Retinal fundus photograph; 45° FOV; image size 2352x1568
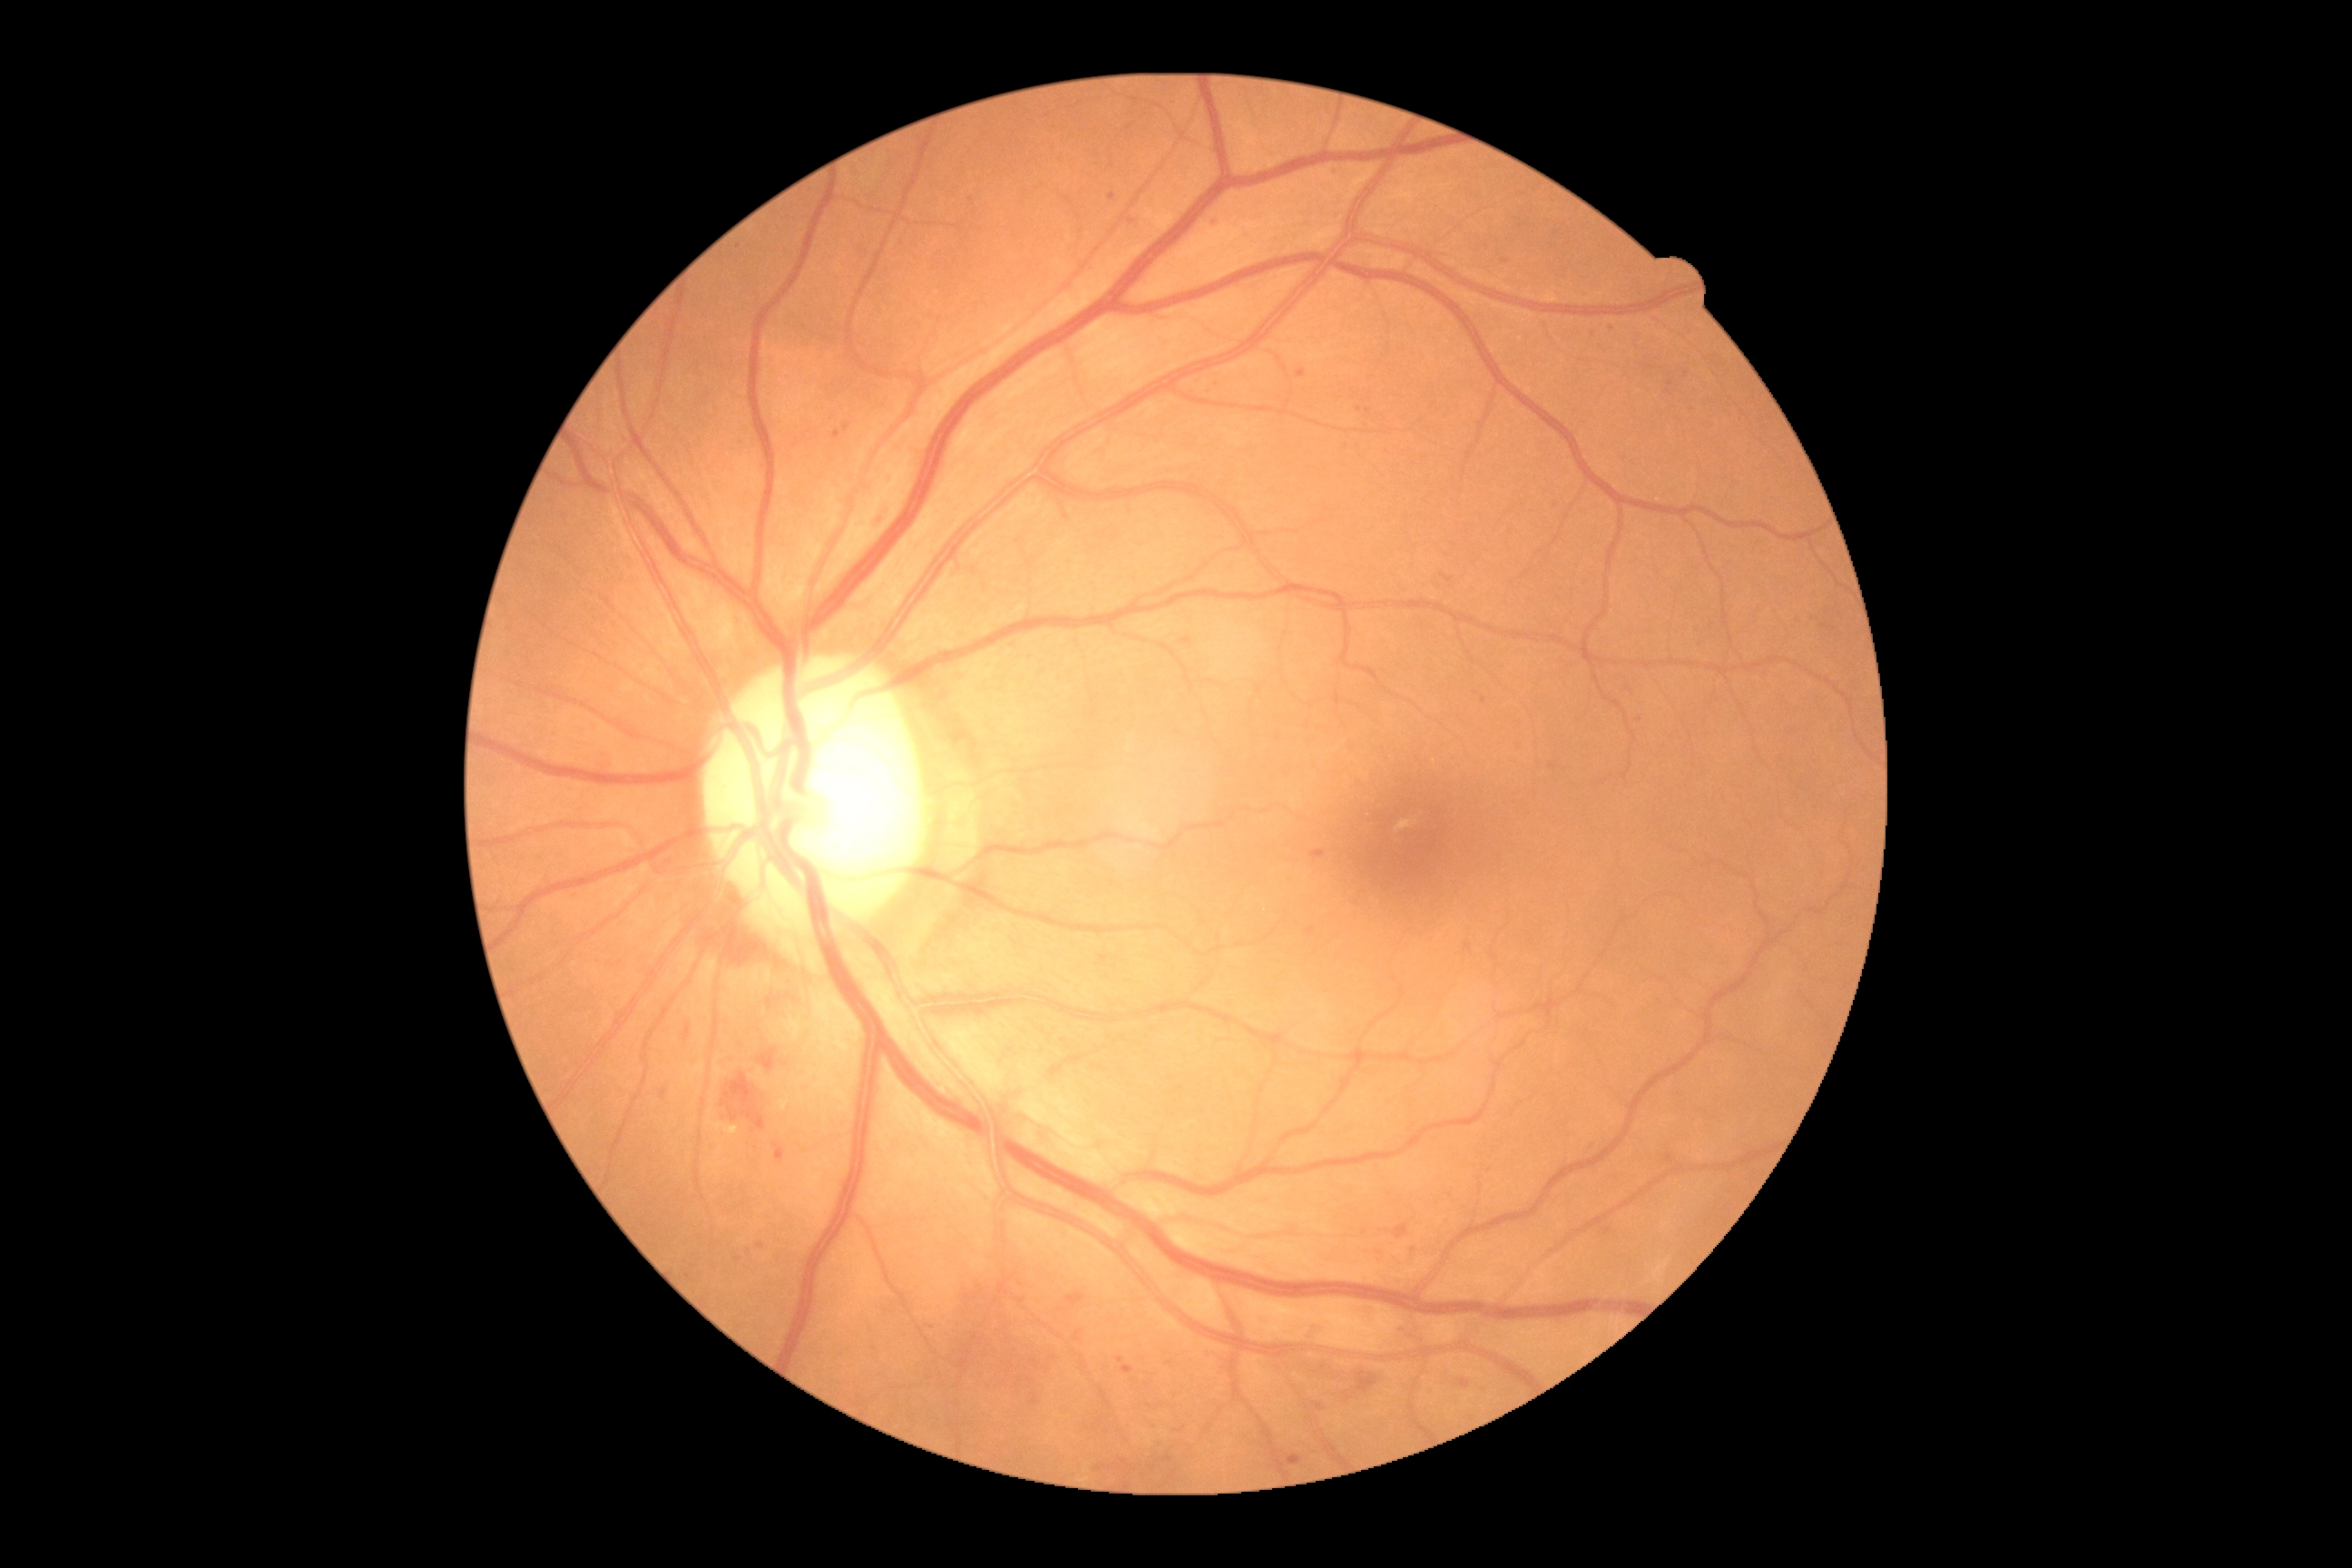

Diabetic retinopathy grade is 2/4.